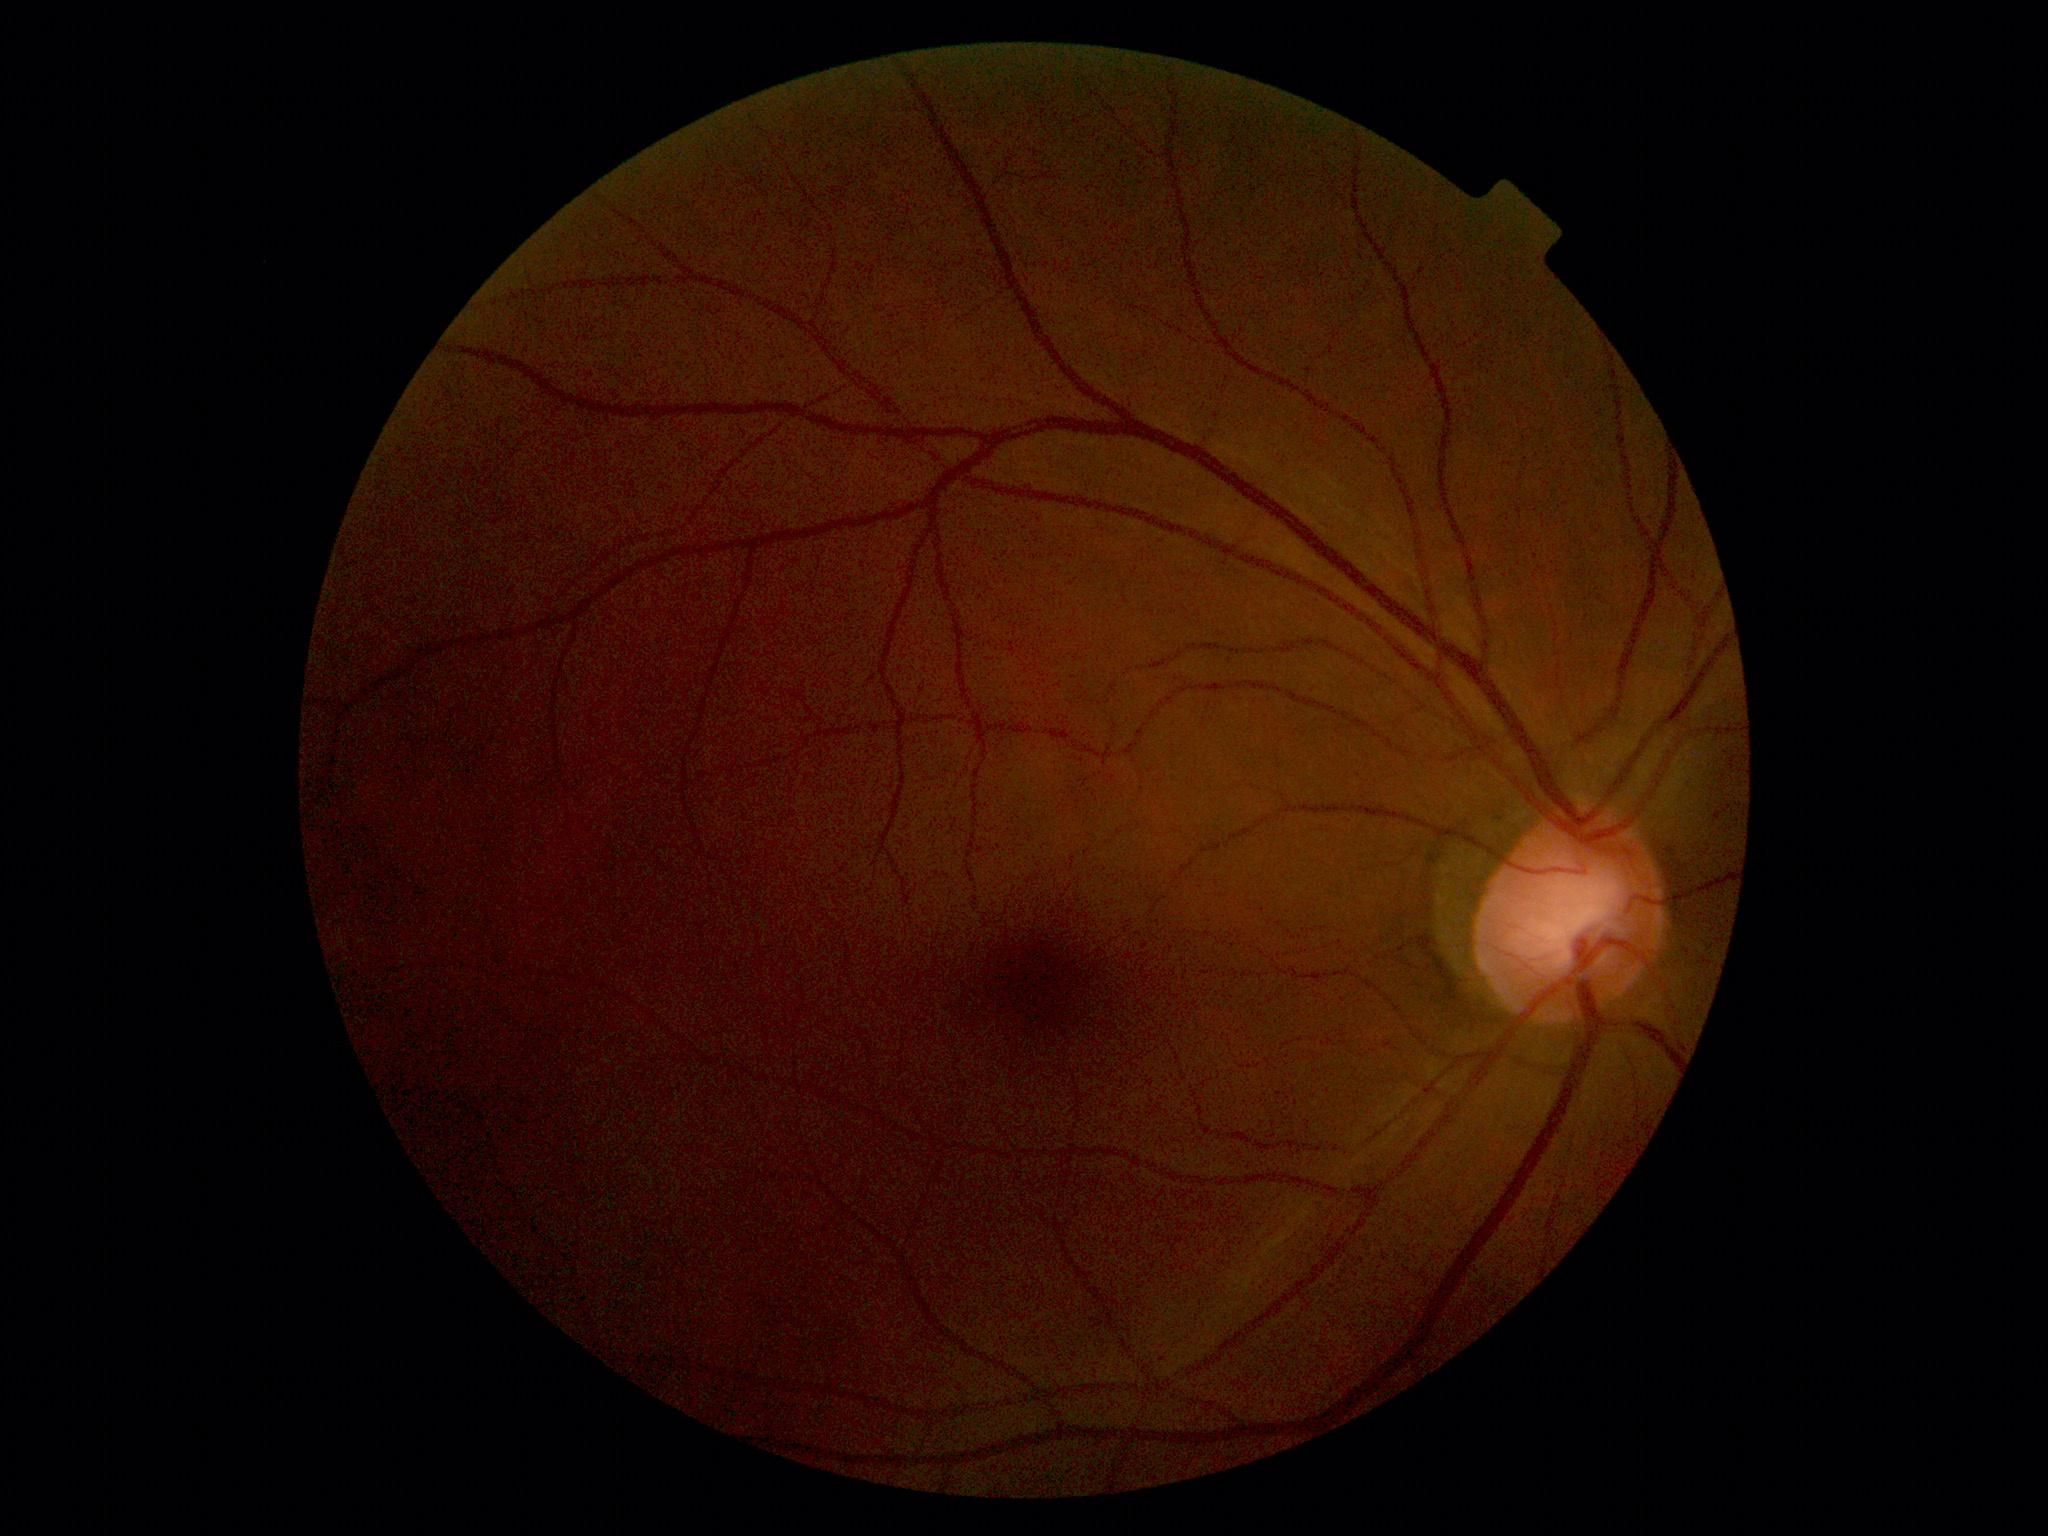
Retinopathy is 0/4.